NIDEK AFC-230; 848x848; 45-degree field of view: 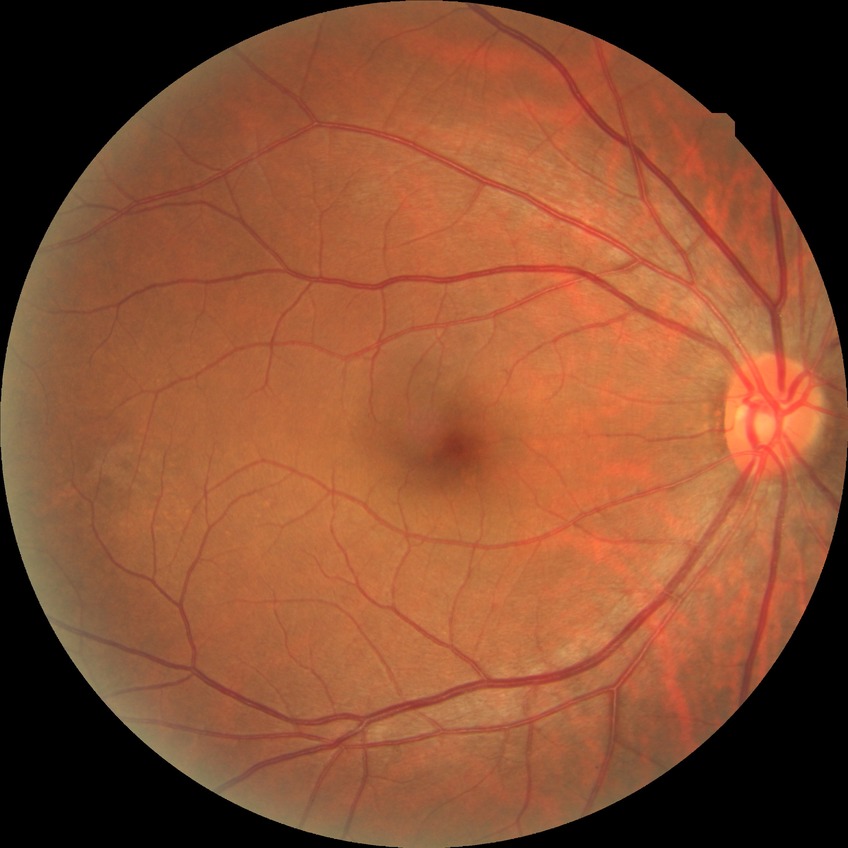

Diabetic retinopathy (DR) is NDR (no diabetic retinopathy).